Acquired with a NIDEK AFC-230 · image size 848x848 · 45° field of view.
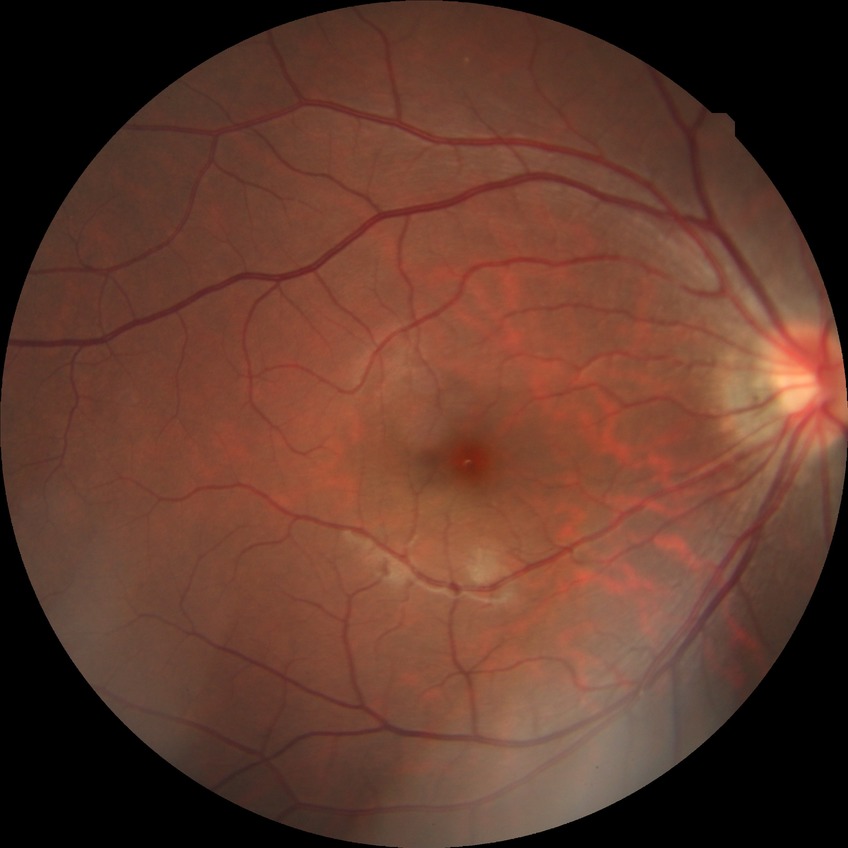 Diabetic retinopathy (DR): NDR (no diabetic retinopathy).